45° field of view. Graded on the modified Davis scale.
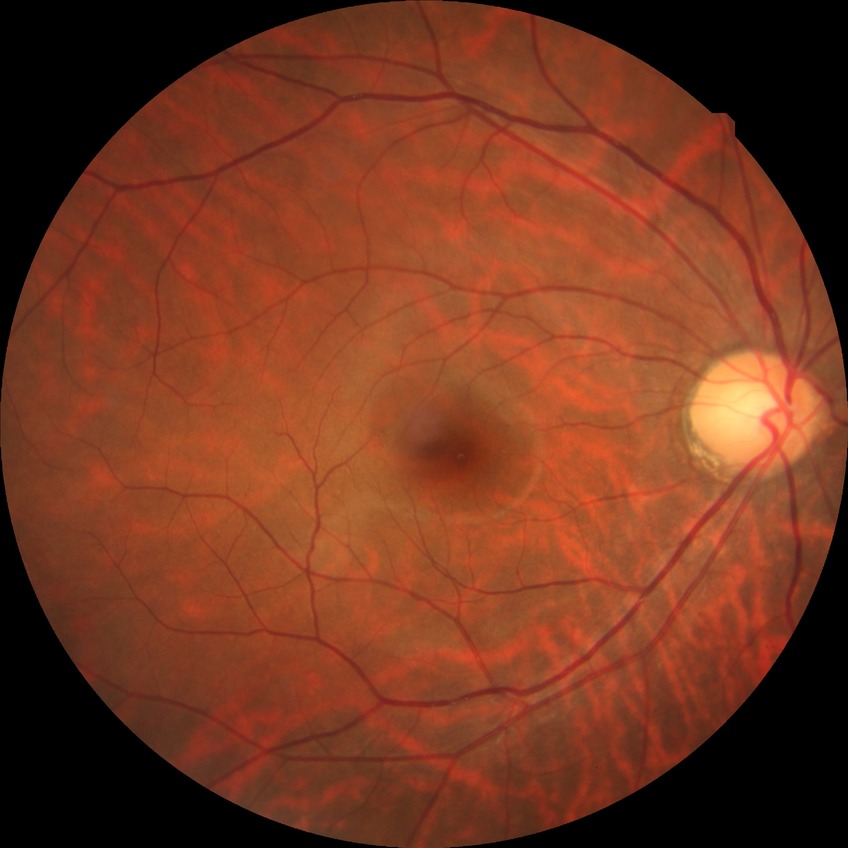 davis_grade: NDR